Modified Davis grading · 45 degree fundus photograph · nonmydriatic · NIDEK AFC-230 fundus camera · color fundus image — 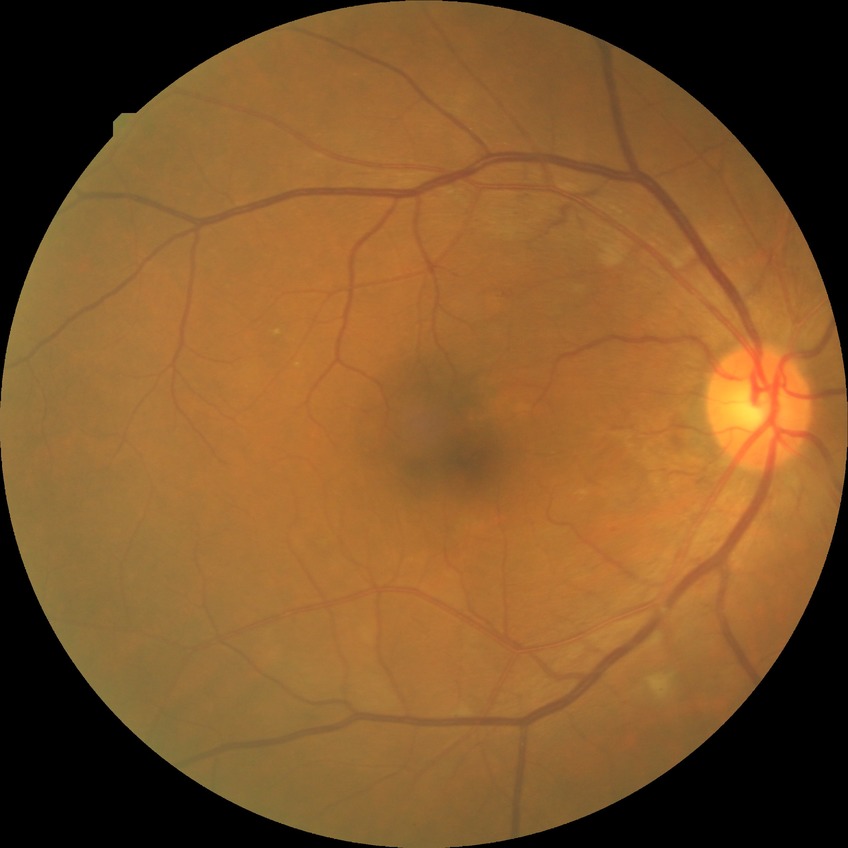 DR is SDR.